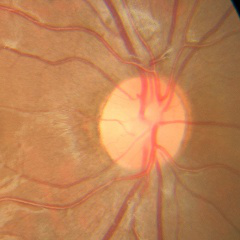 Optic nerve head appearance consistent with no glaucomatous changes.